Nonmydriatic; camera: NIDEK AFC-230.
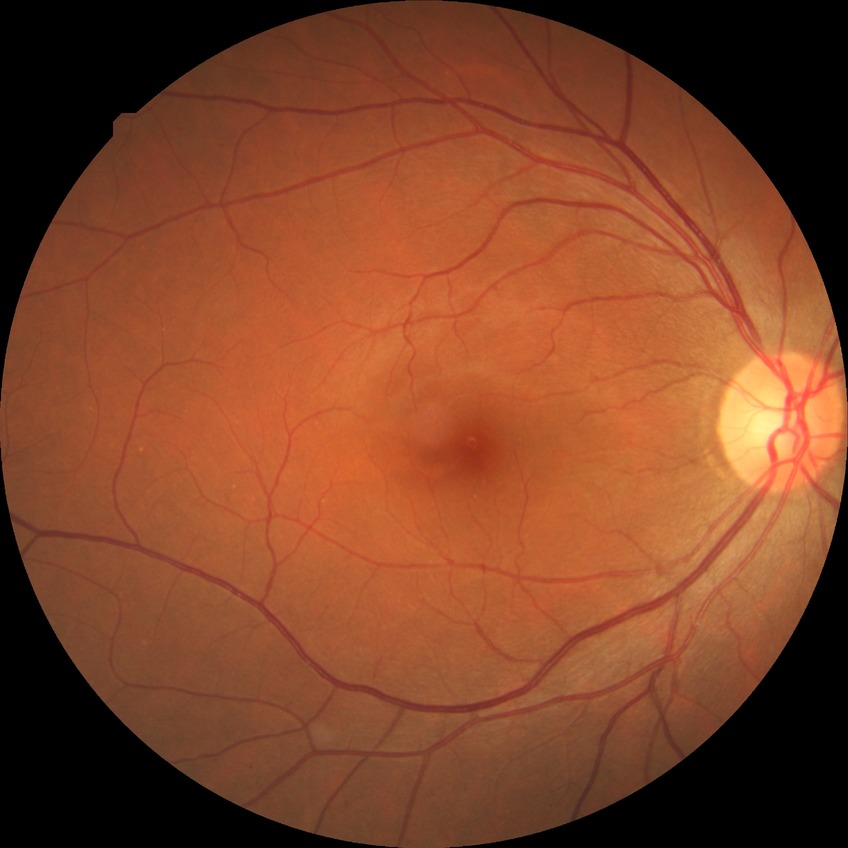 Diabetic retinopathy (DR): NDR (no diabetic retinopathy).